45° field of view. 848x848: 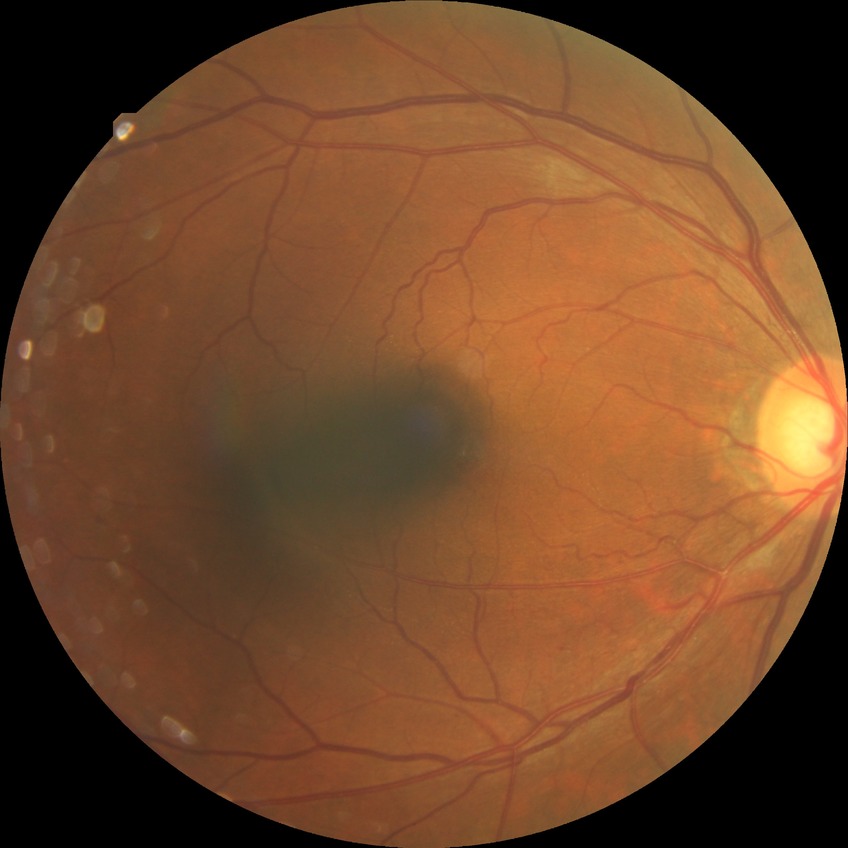 Davis stage@NDR.